848 x 848 pixels; posterior pole color fundus photograph; nonmydriatic fundus photograph — 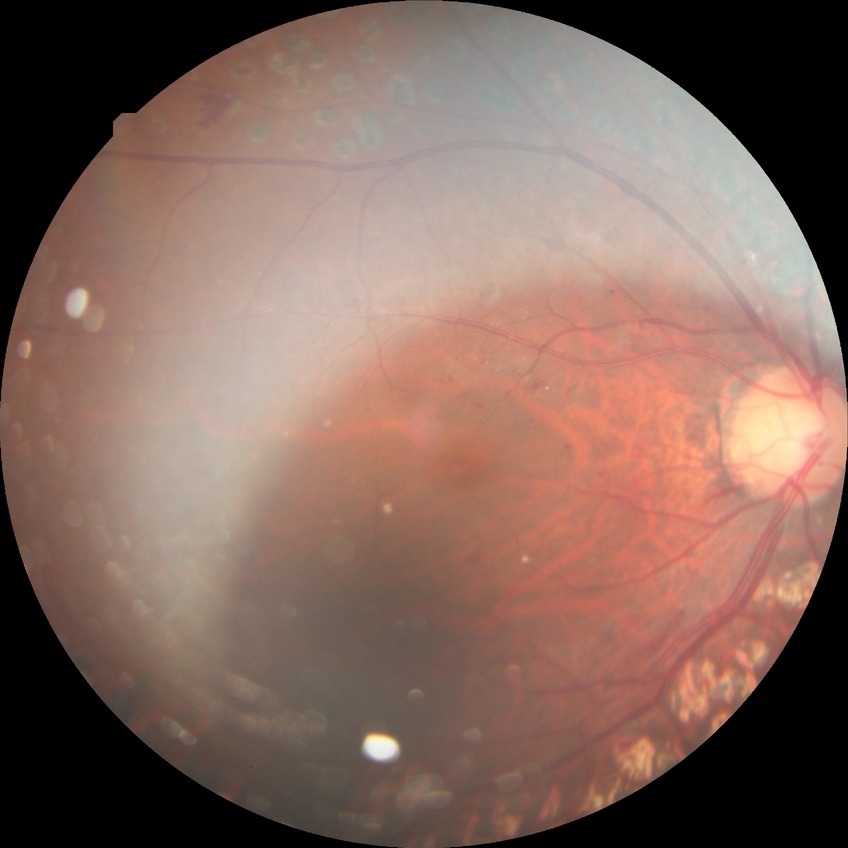
diabetic retinopathy (DR) = PDR (proliferative diabetic retinopathy).